Captured with the Phoenix ICON (100° field of view) · 1240x1240px · wide-field fundus photograph from neonatal ROP screening: 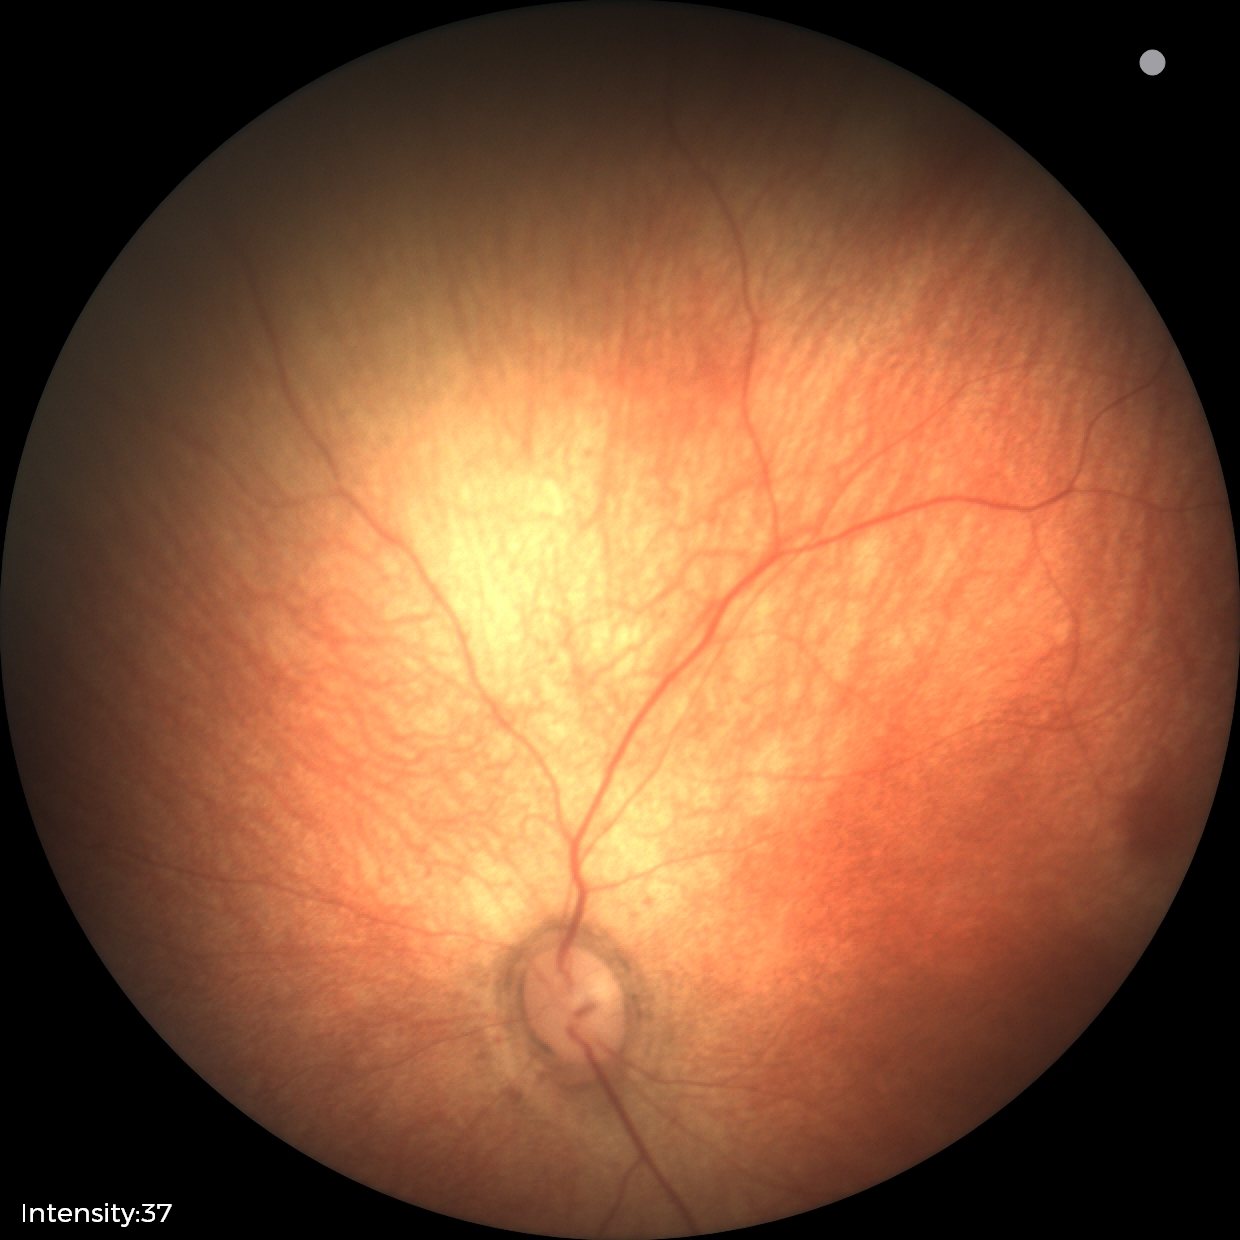 Screening diagnosis: normal retinal appearance.